Non-mydriatic
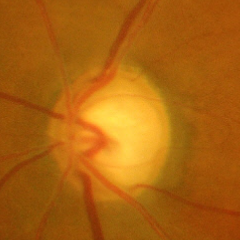 Demonstrates advanced glaucomatous optic neuropathy. Diagnostic criteria: near-total cupping of the optic nerve head, with or without severe visual field loss within the central 10 degrees of fixation.